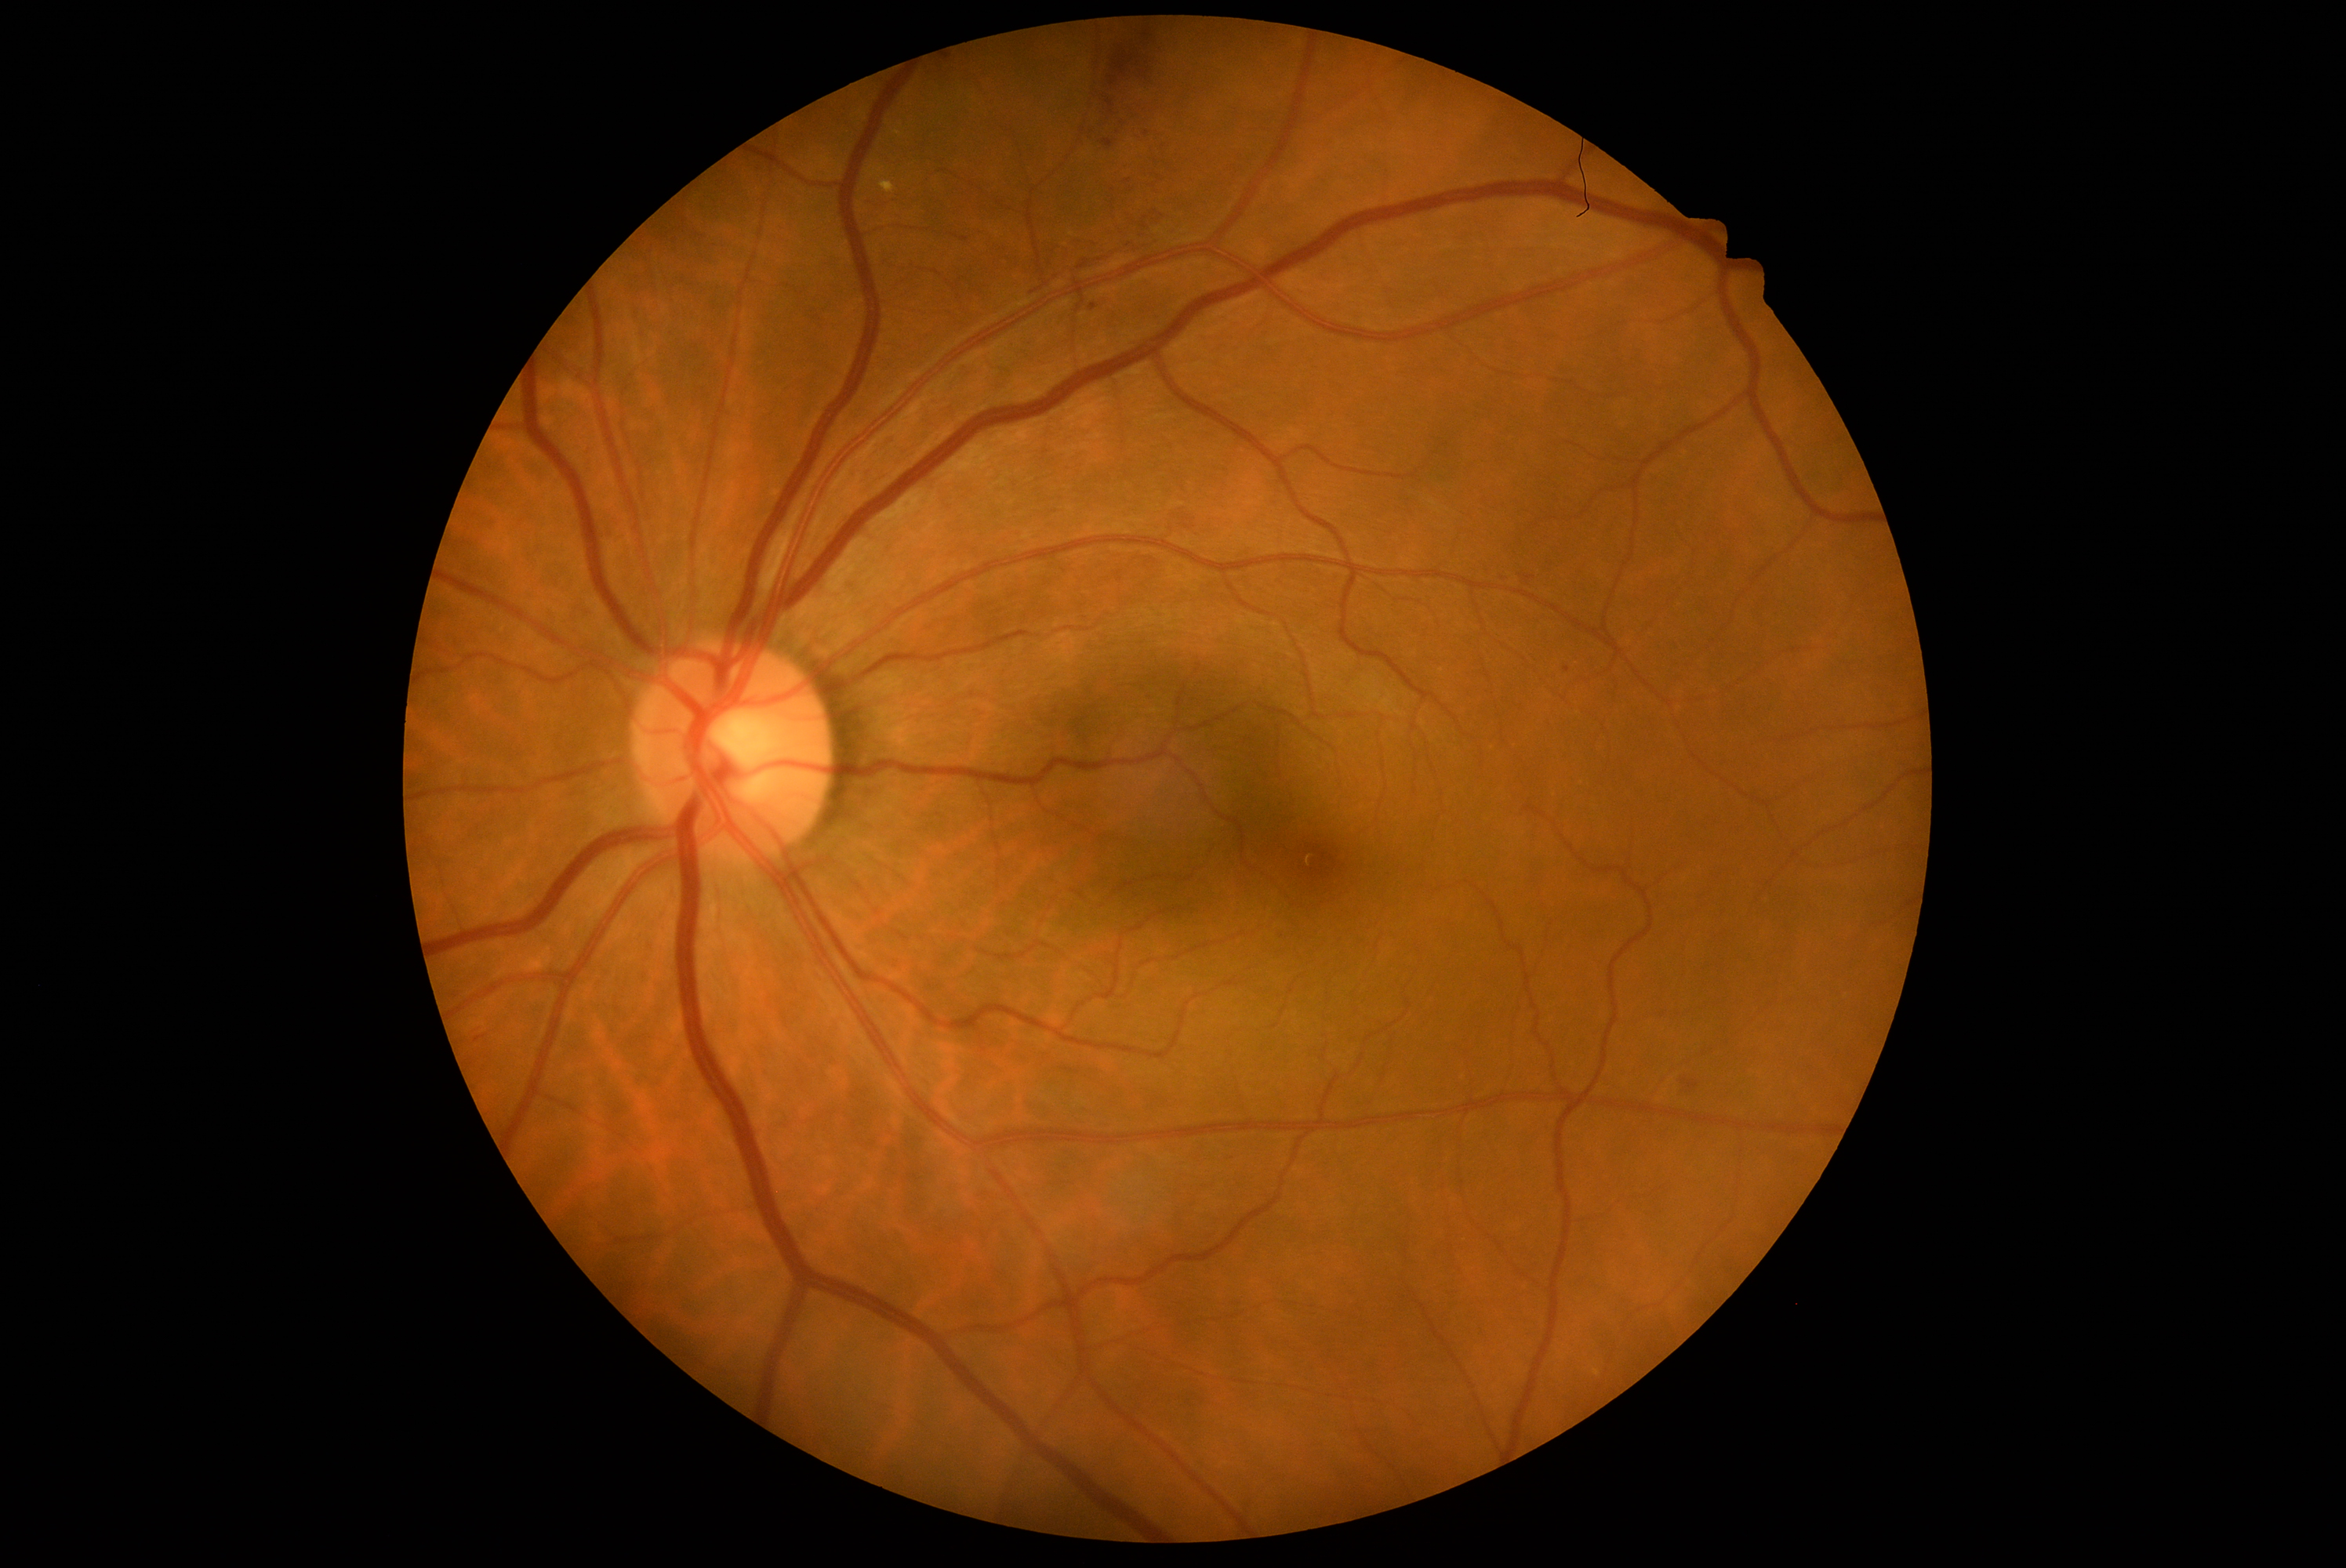

DR severity is moderate NPDR (grade 2).